Modified Davis classification. Nonmydriatic — 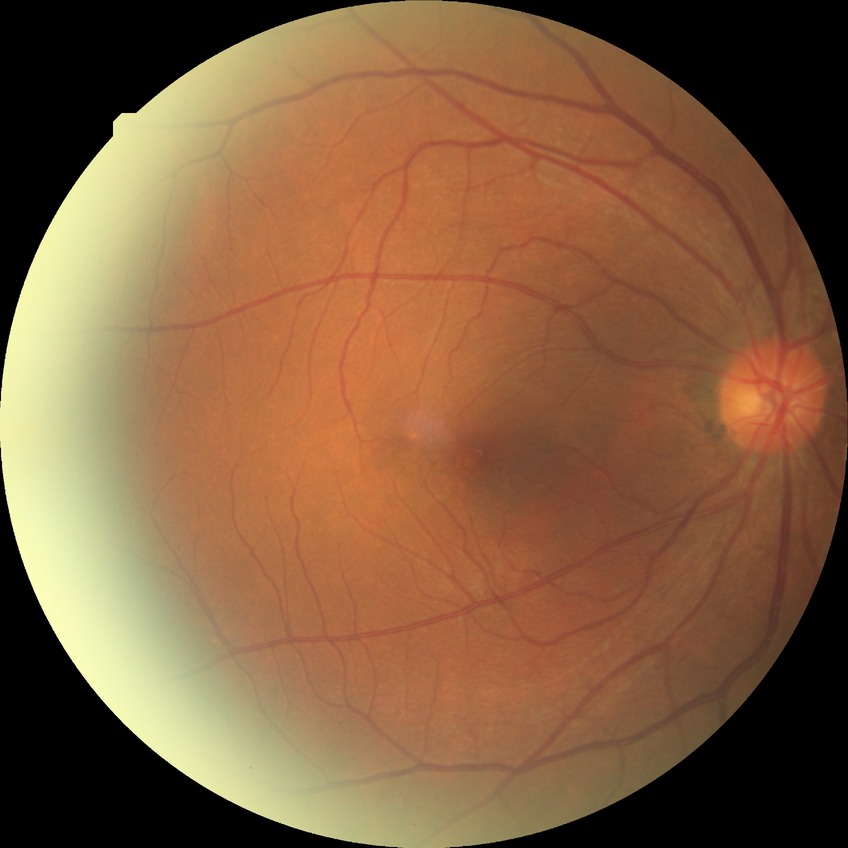

Diabetic retinopathy (DR): no diabetic retinopathy (NDR).